Modified Davis grading
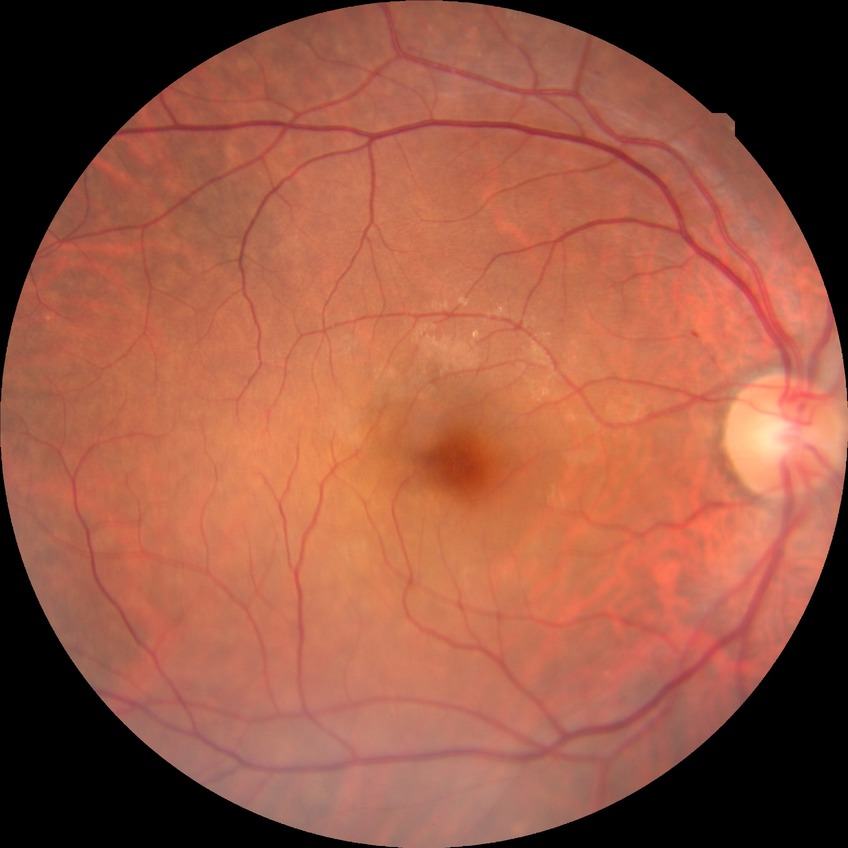 Diabetic retinopathy (DR): simple diabetic retinopathy (SDR).